Fundus photo: 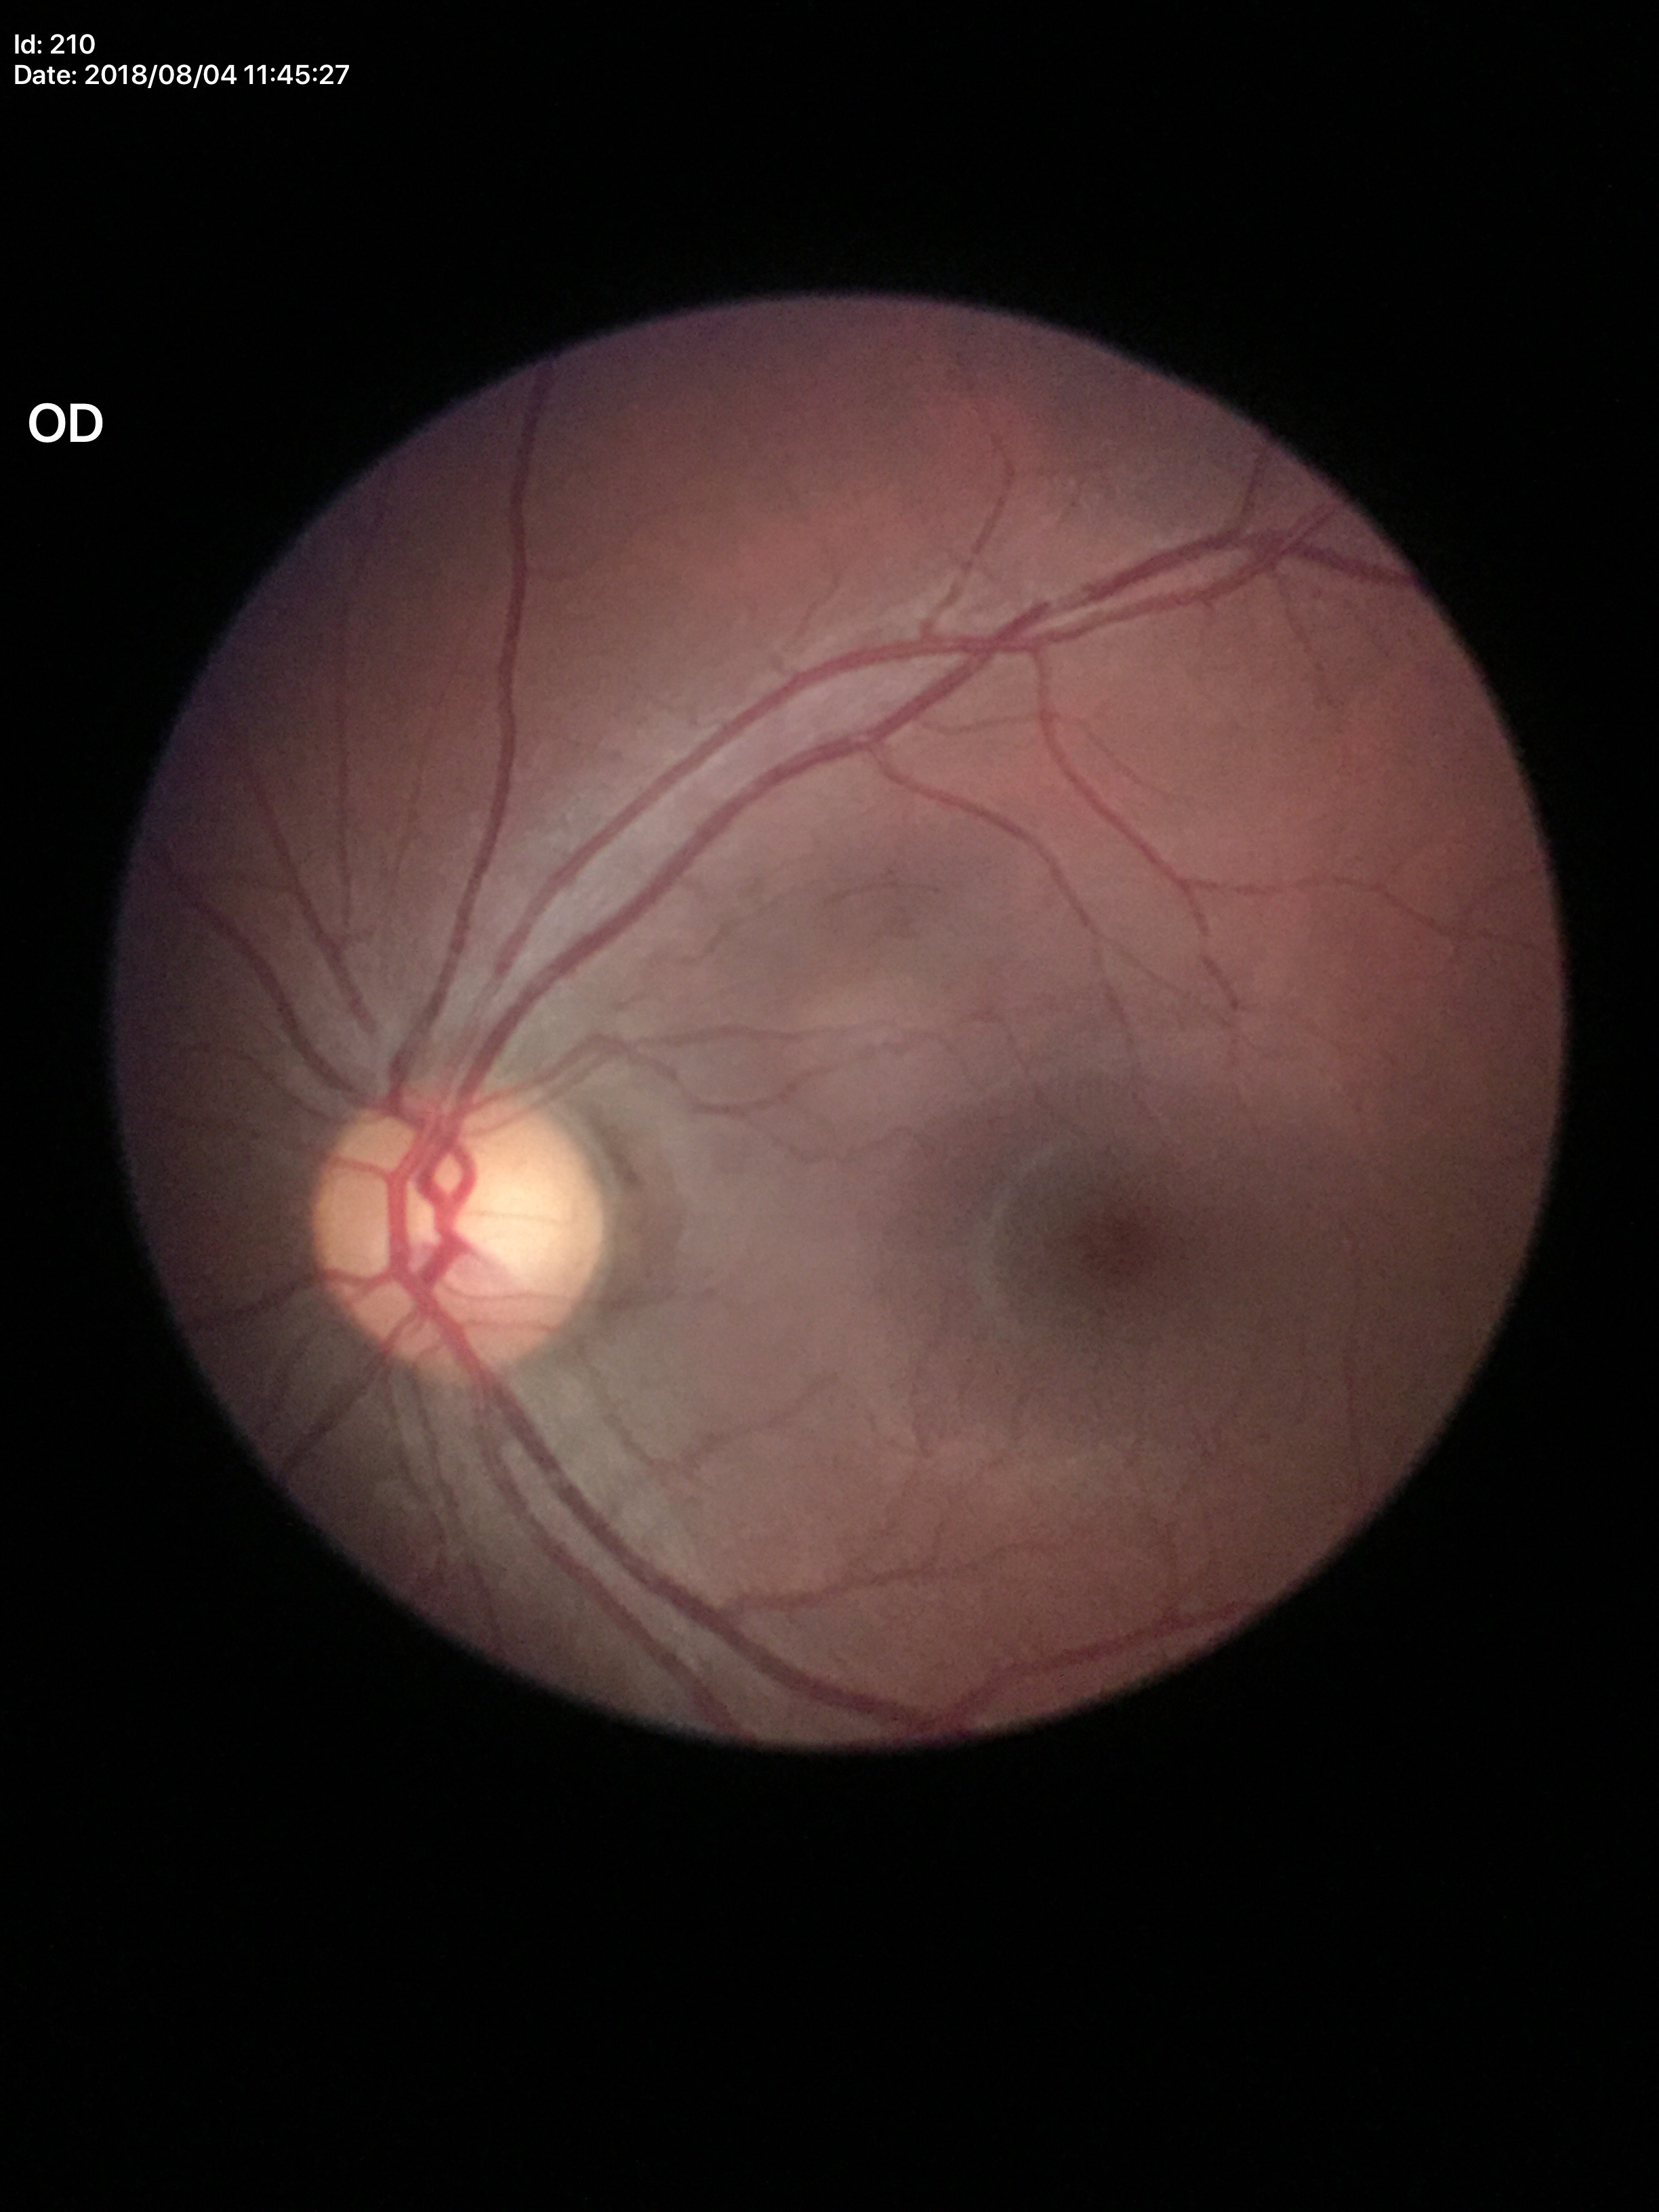 Glaucoma evaluation: suspicious | vertical CDR (VCDR): 0.60.